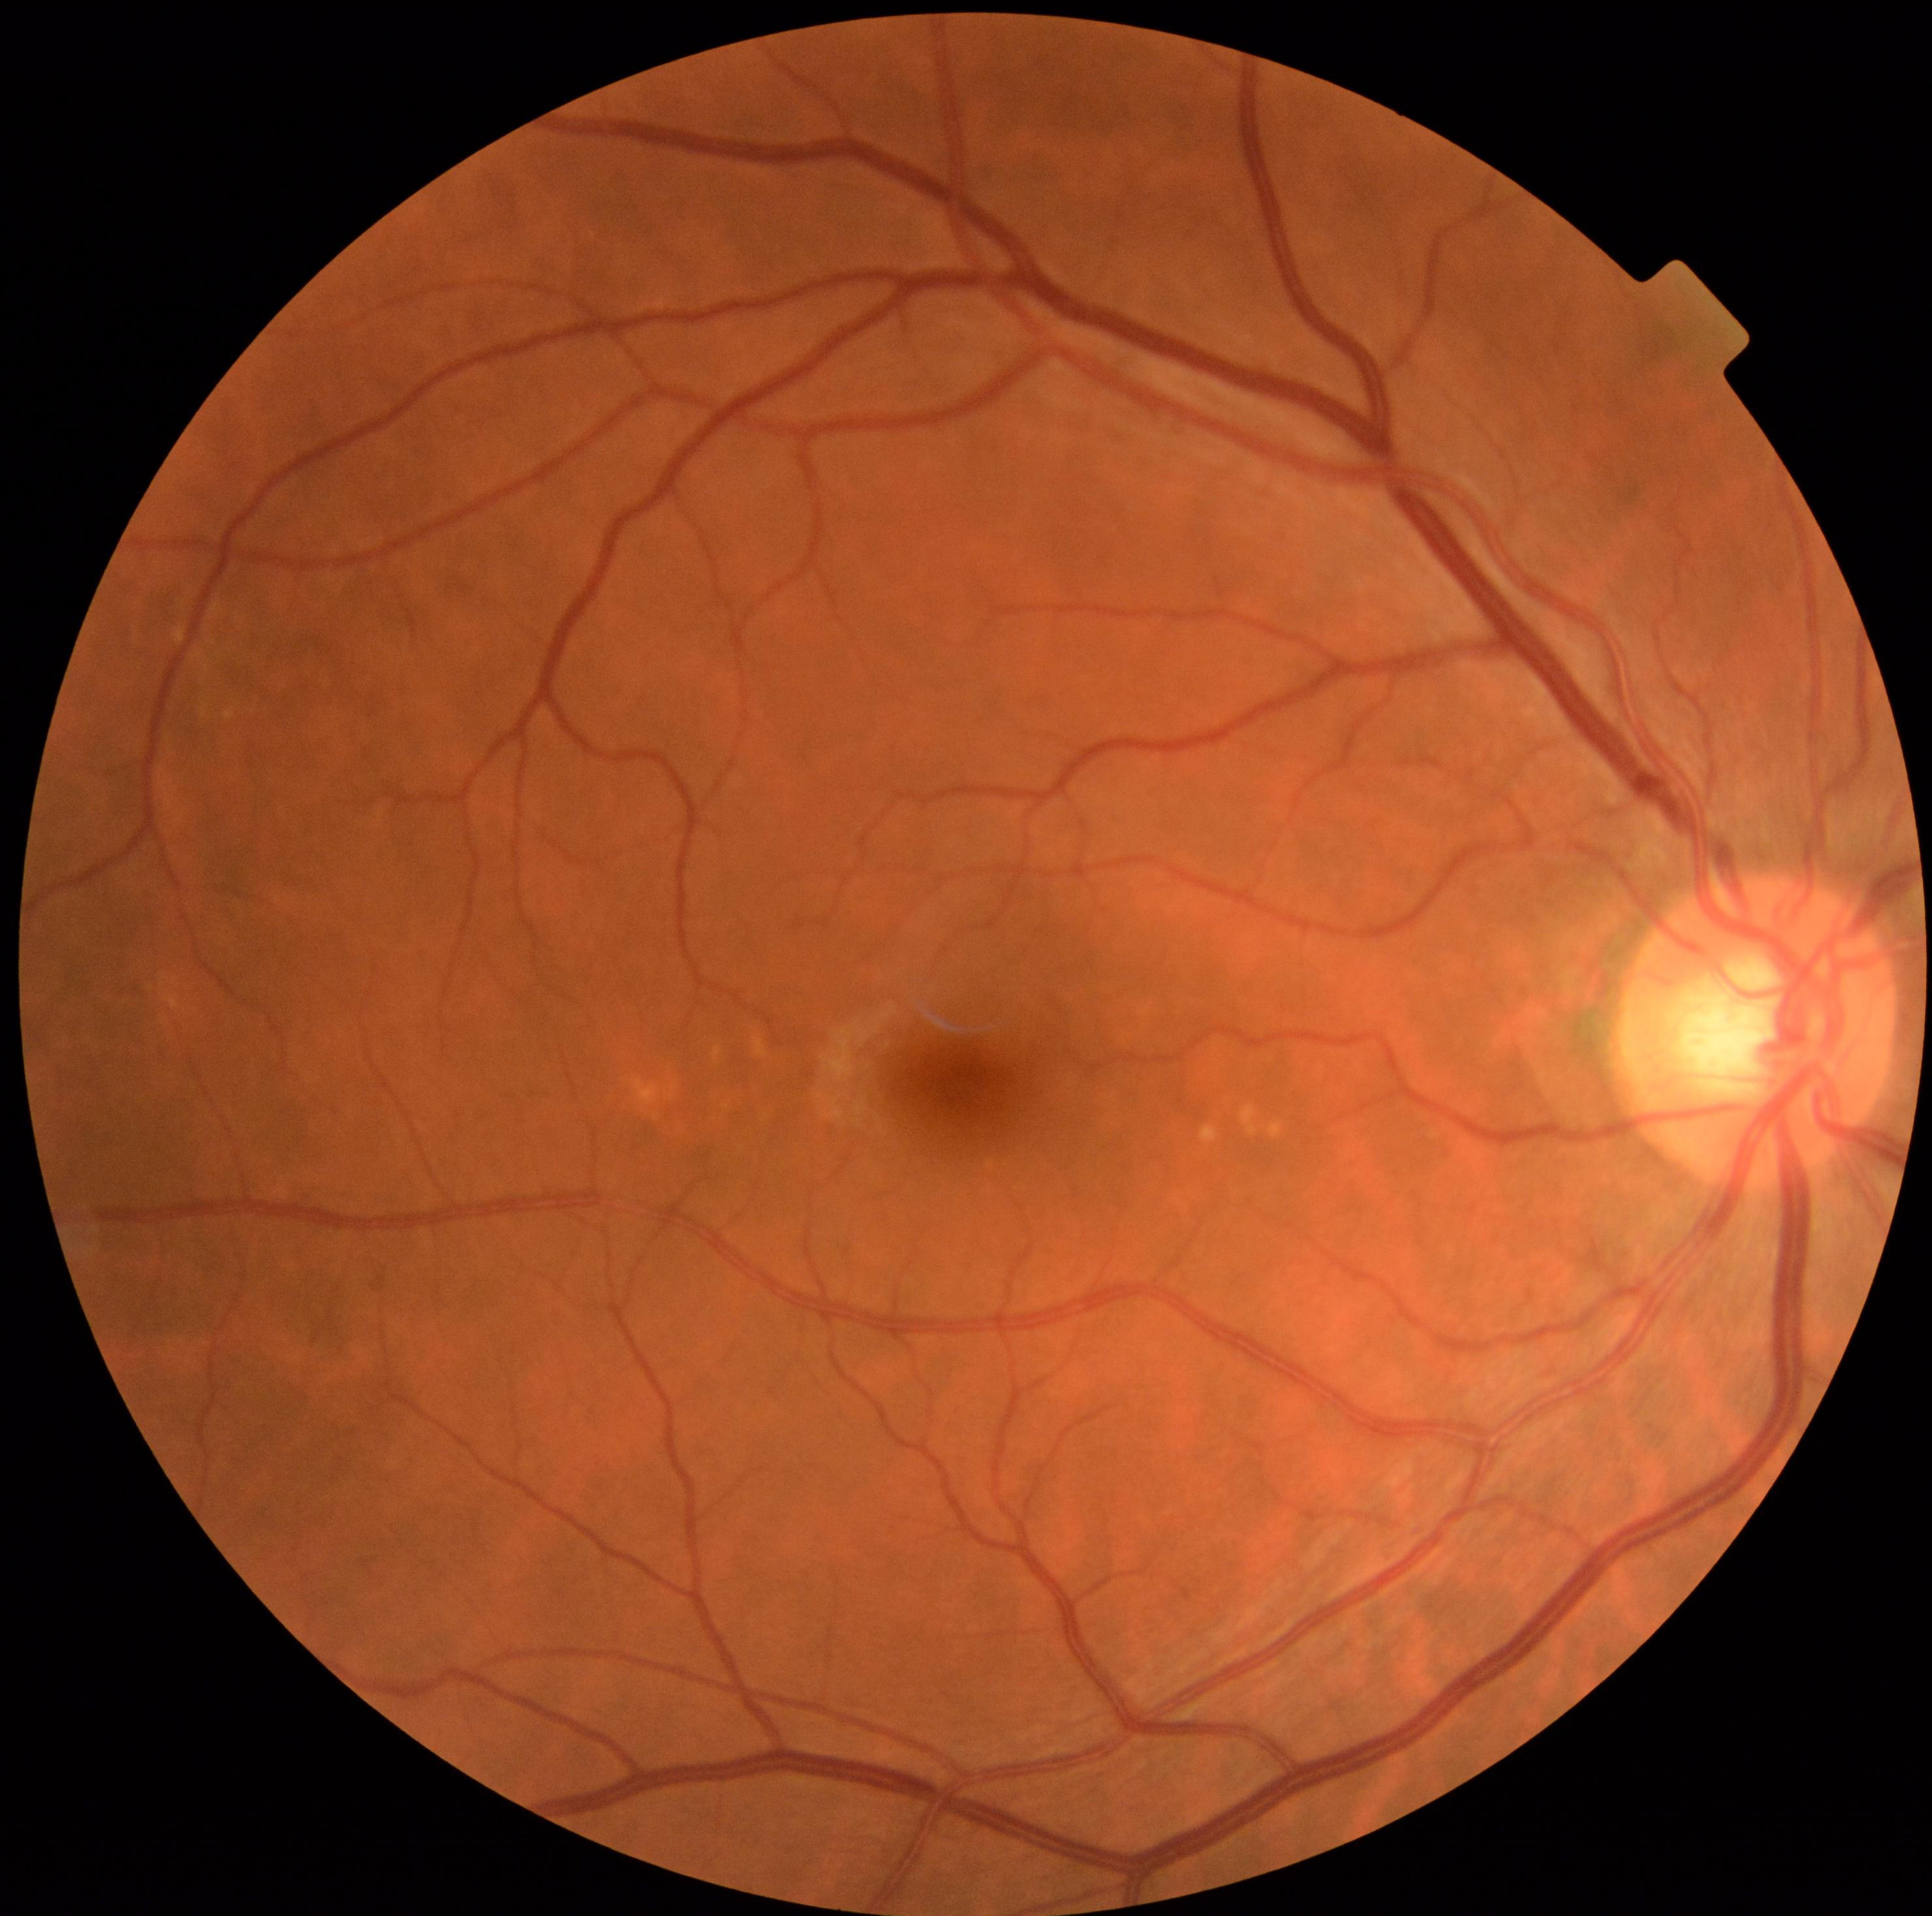

DR: 0.